512x512px — 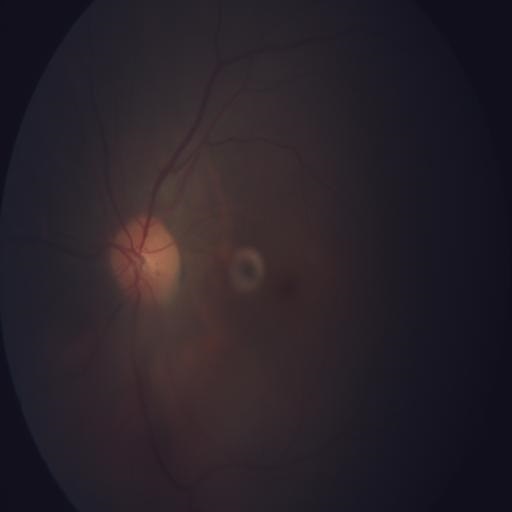
2 abnormalities. This fundus photograph shows media haze & optic disc edema.